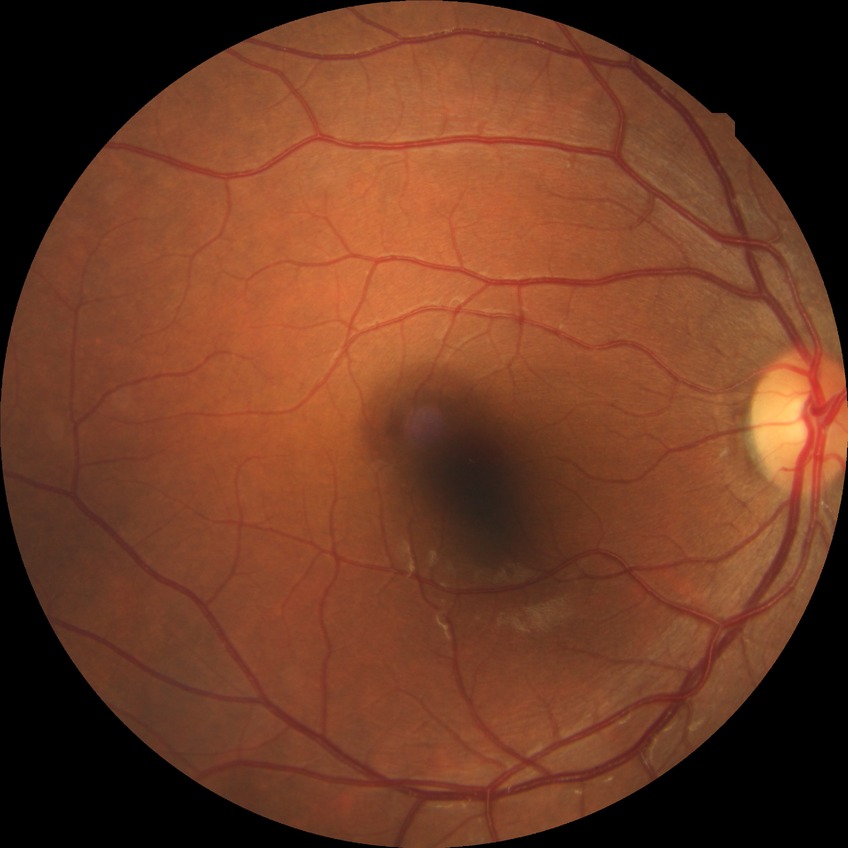

Diabetic retinopathy (DR): NDR (no diabetic retinopathy).